2089x1764px
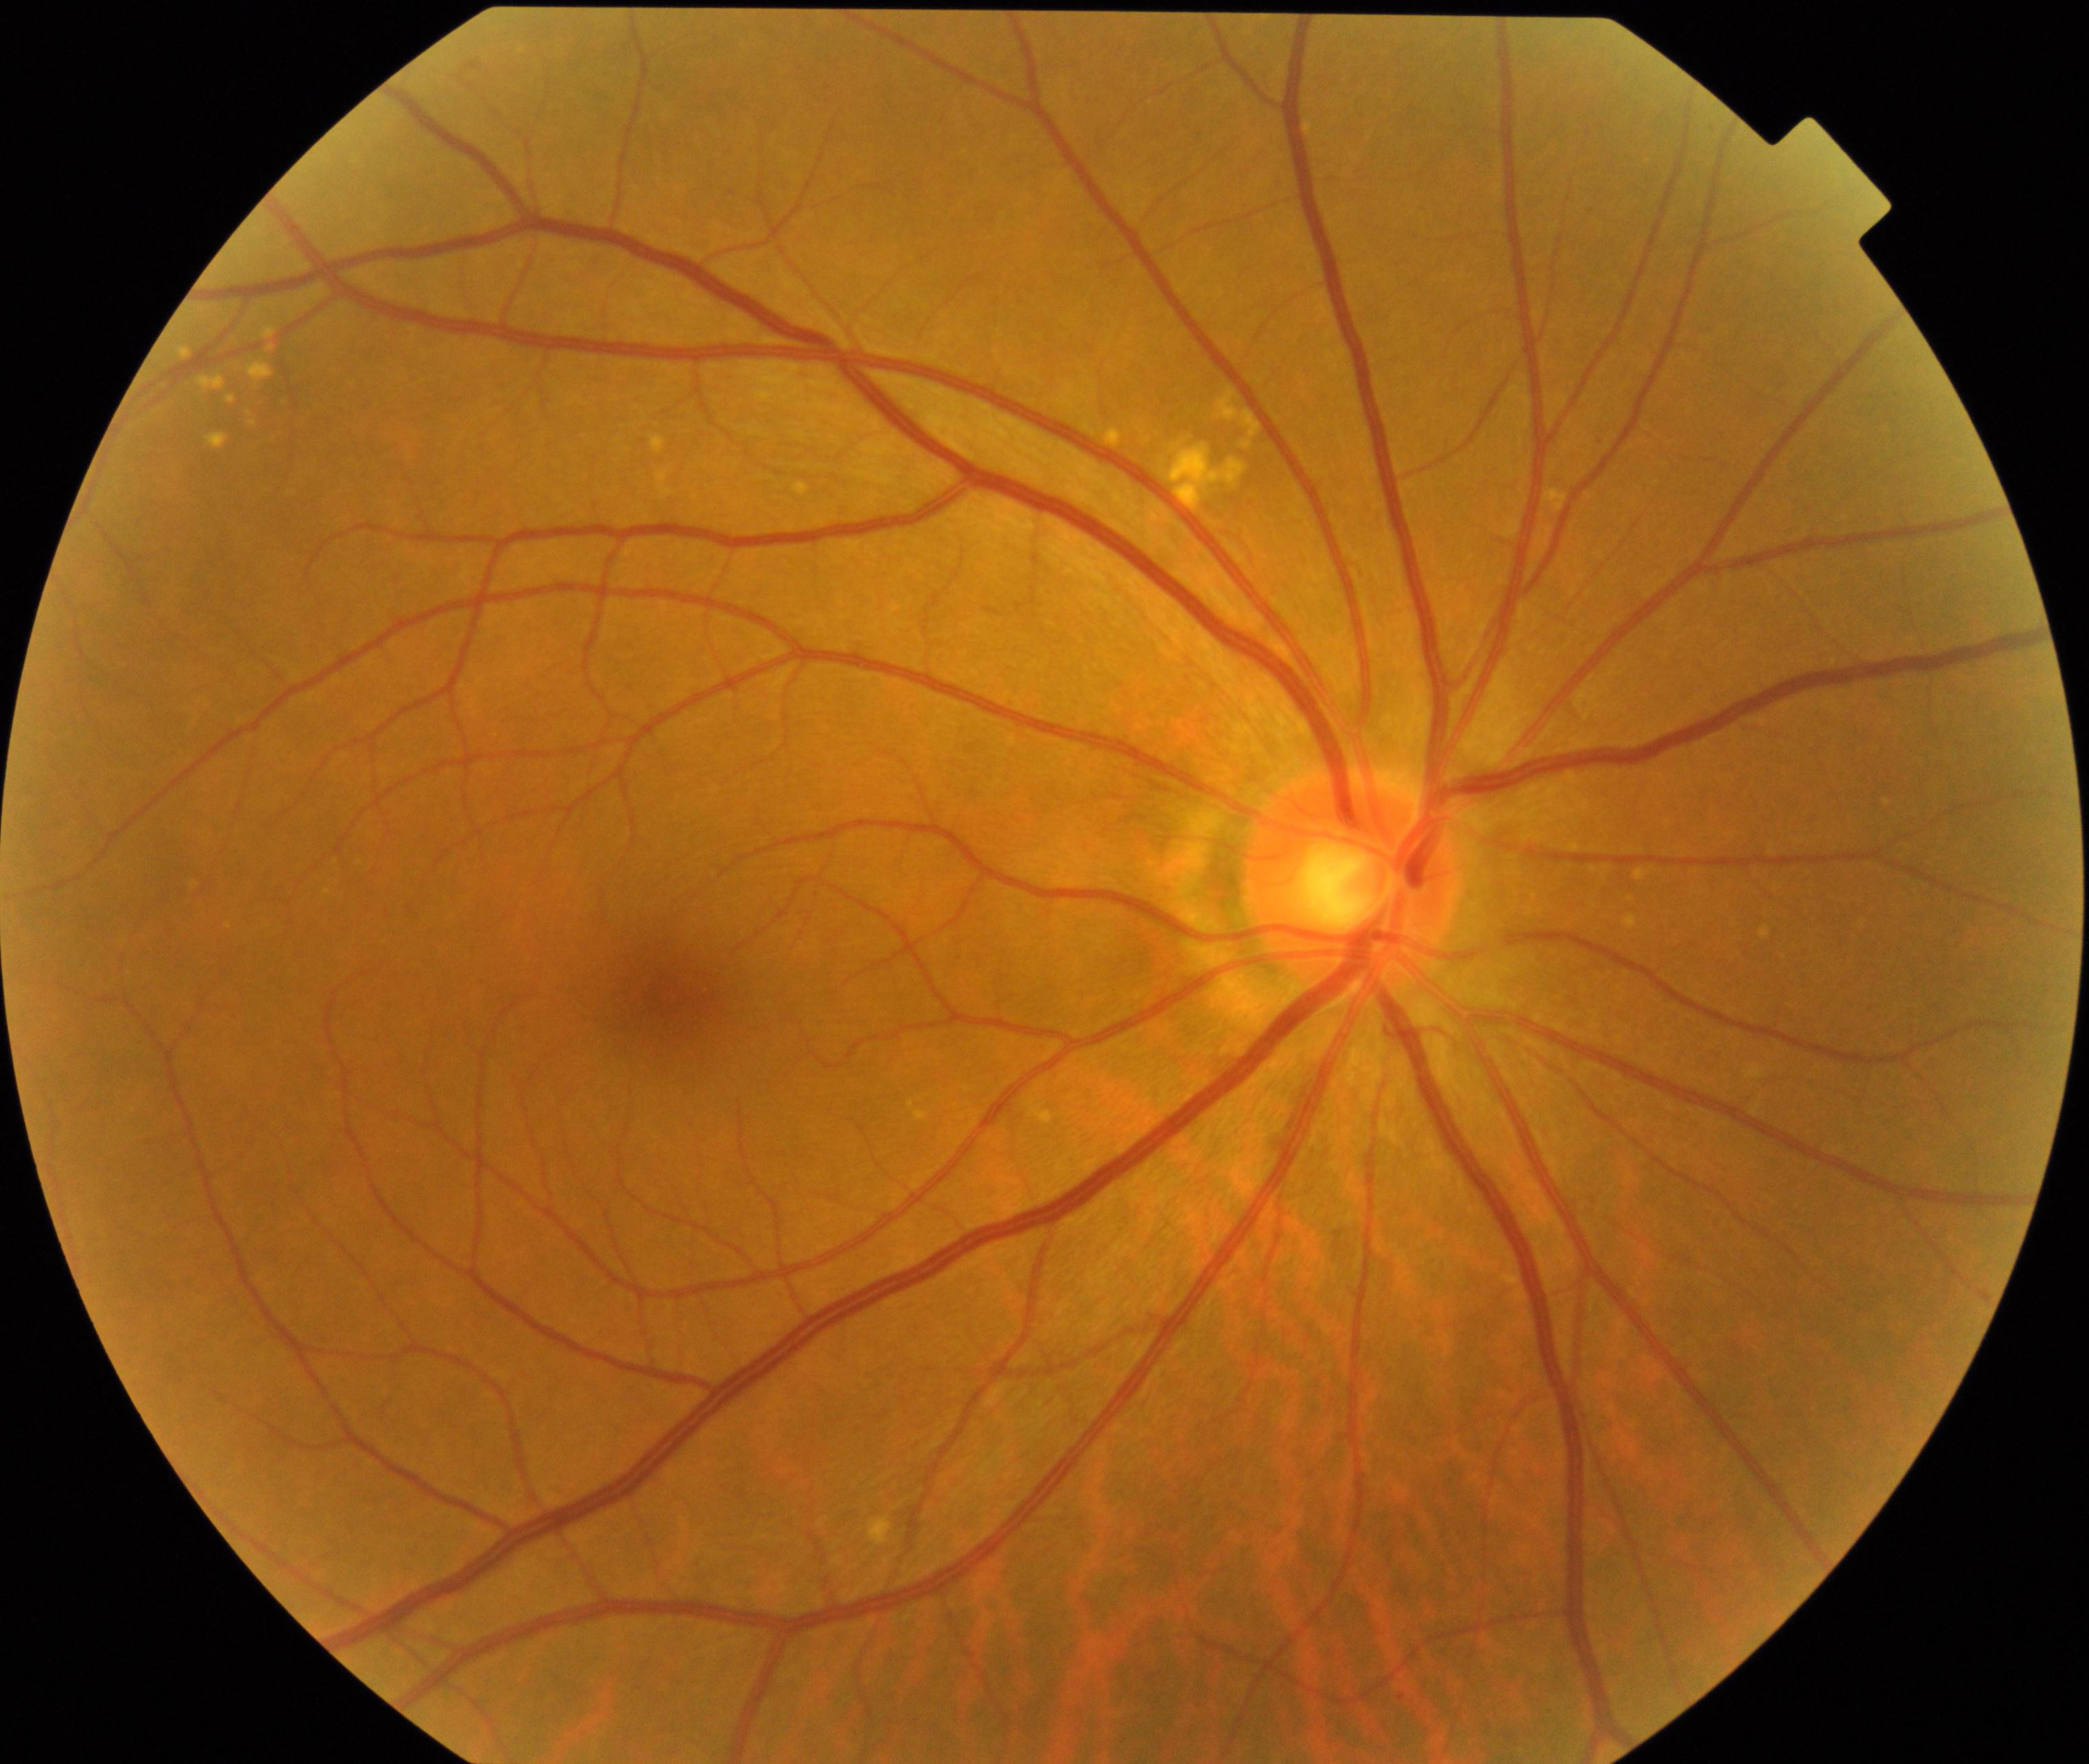
Appearance consistent with yellow-white spots or flecks.